2352x1568; color fundus image; 45-degree field of view: 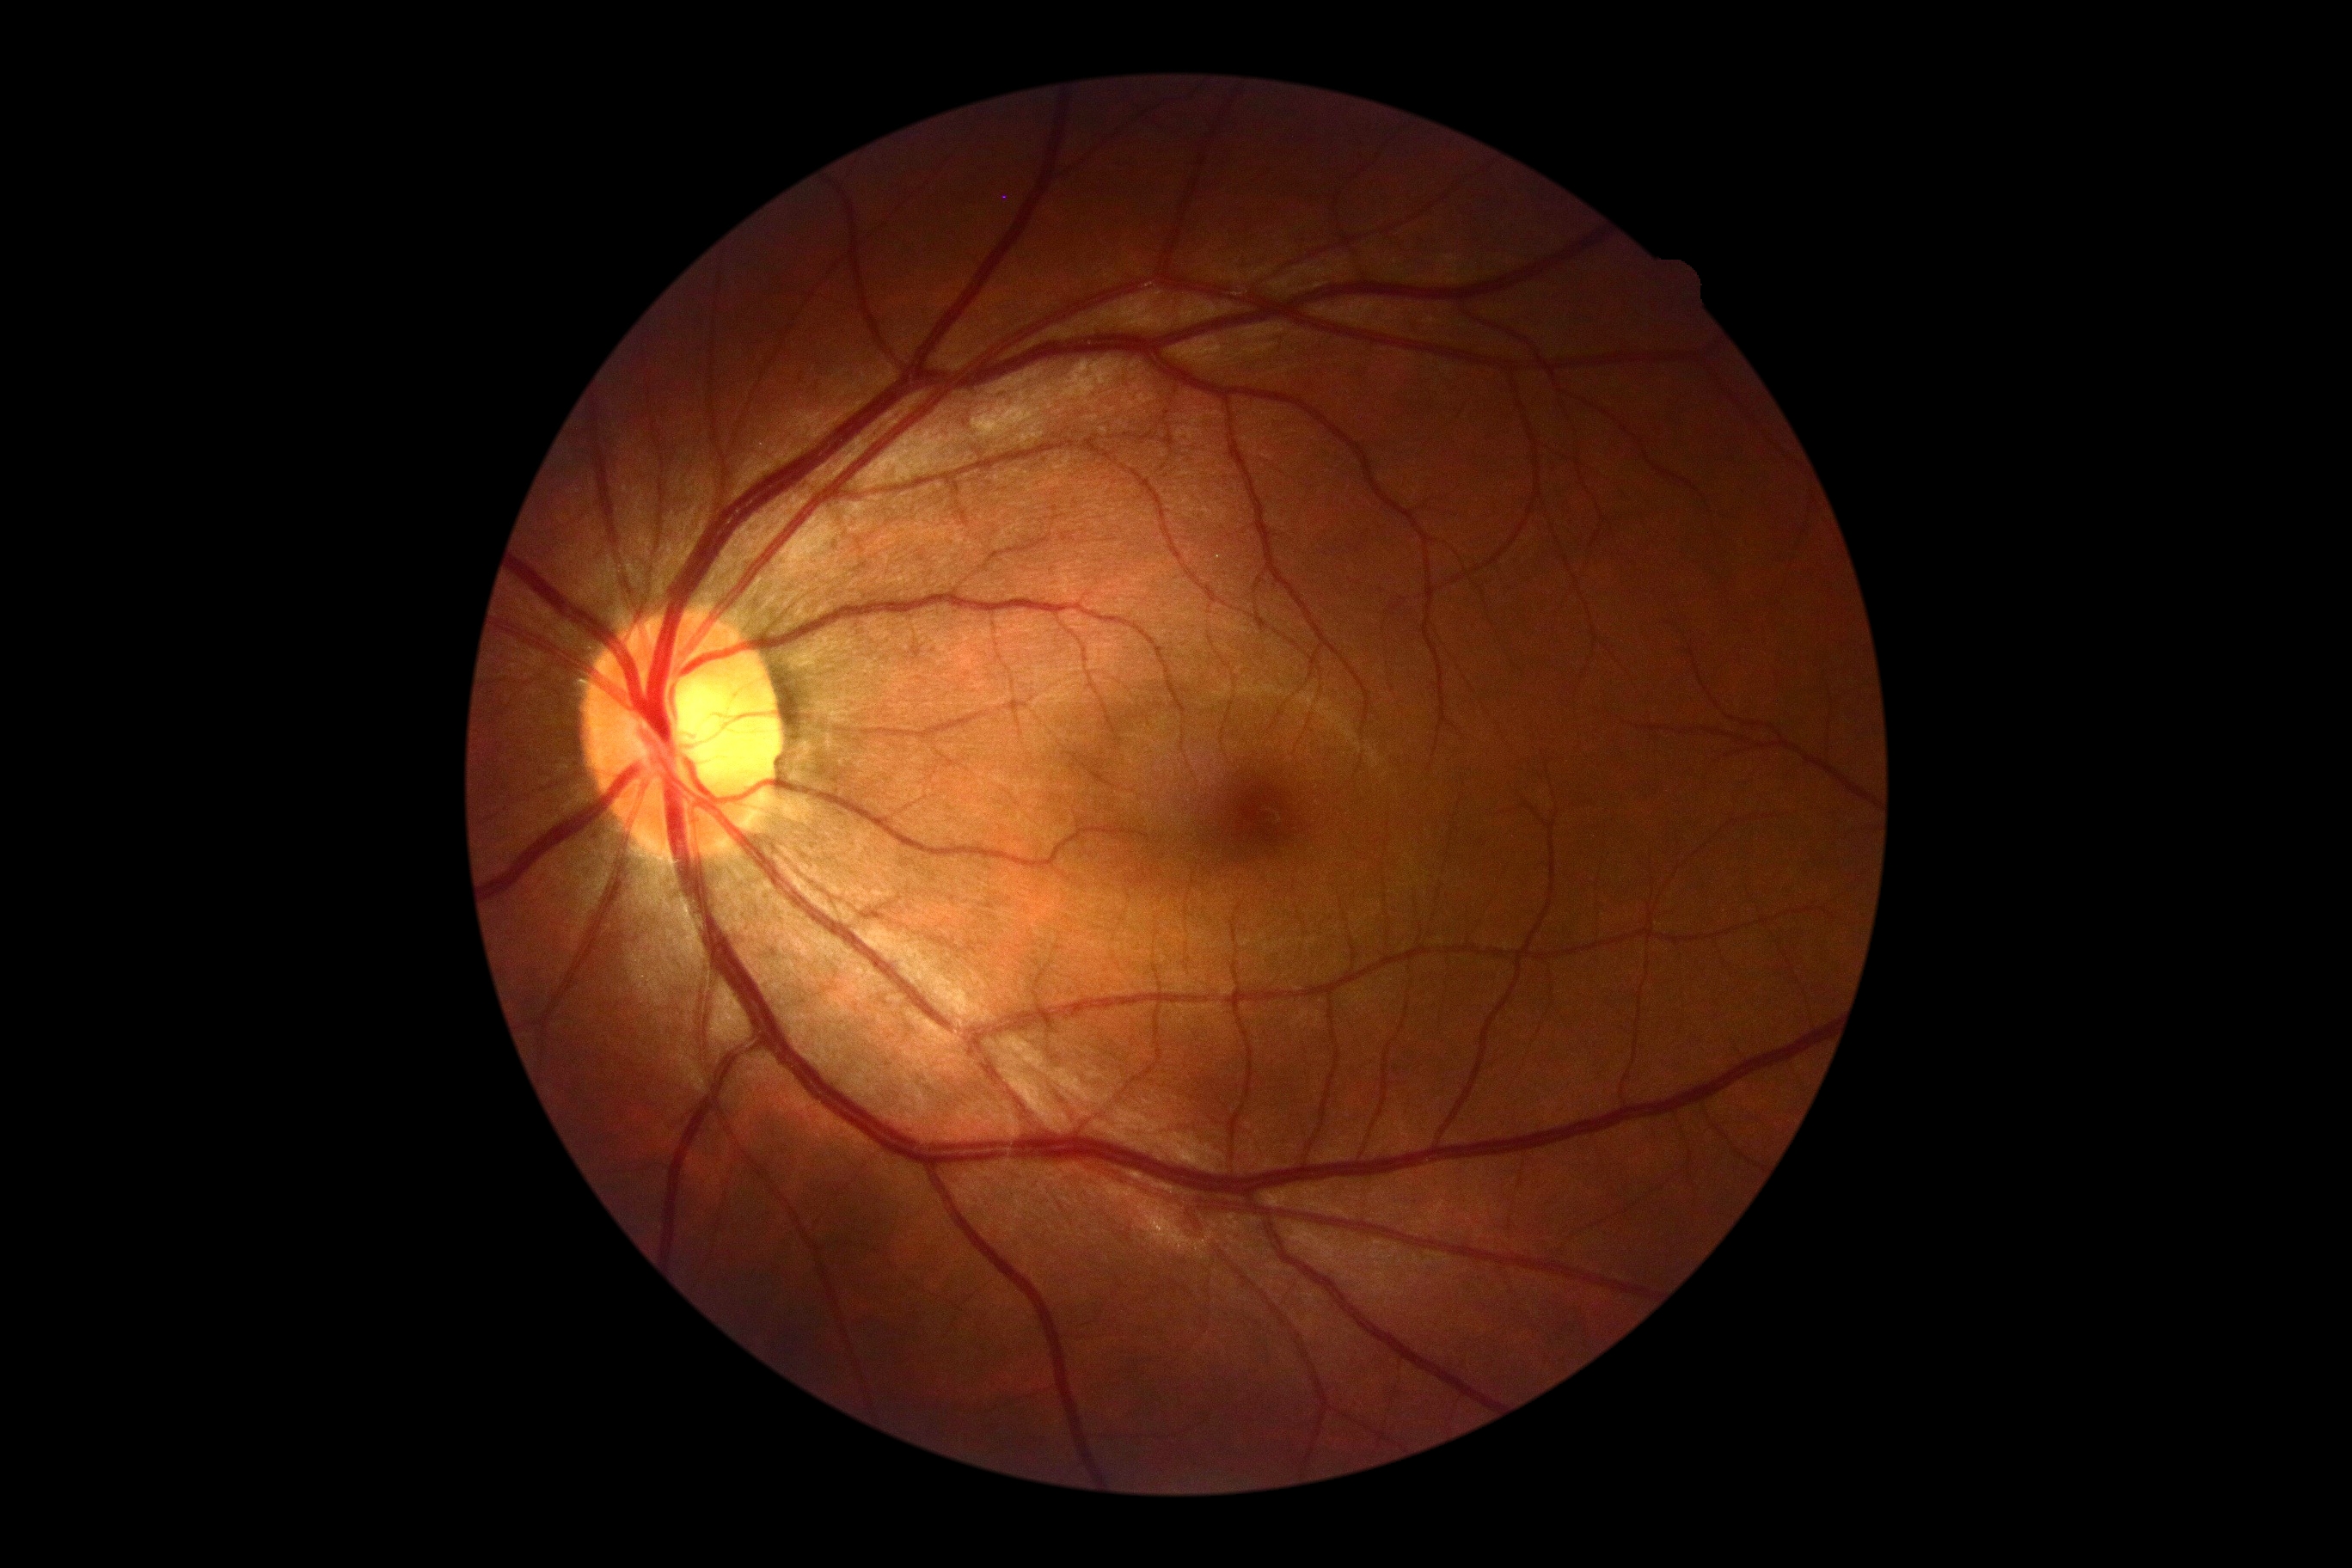 No apparent diabetic retinopathy. DR stage: 0.